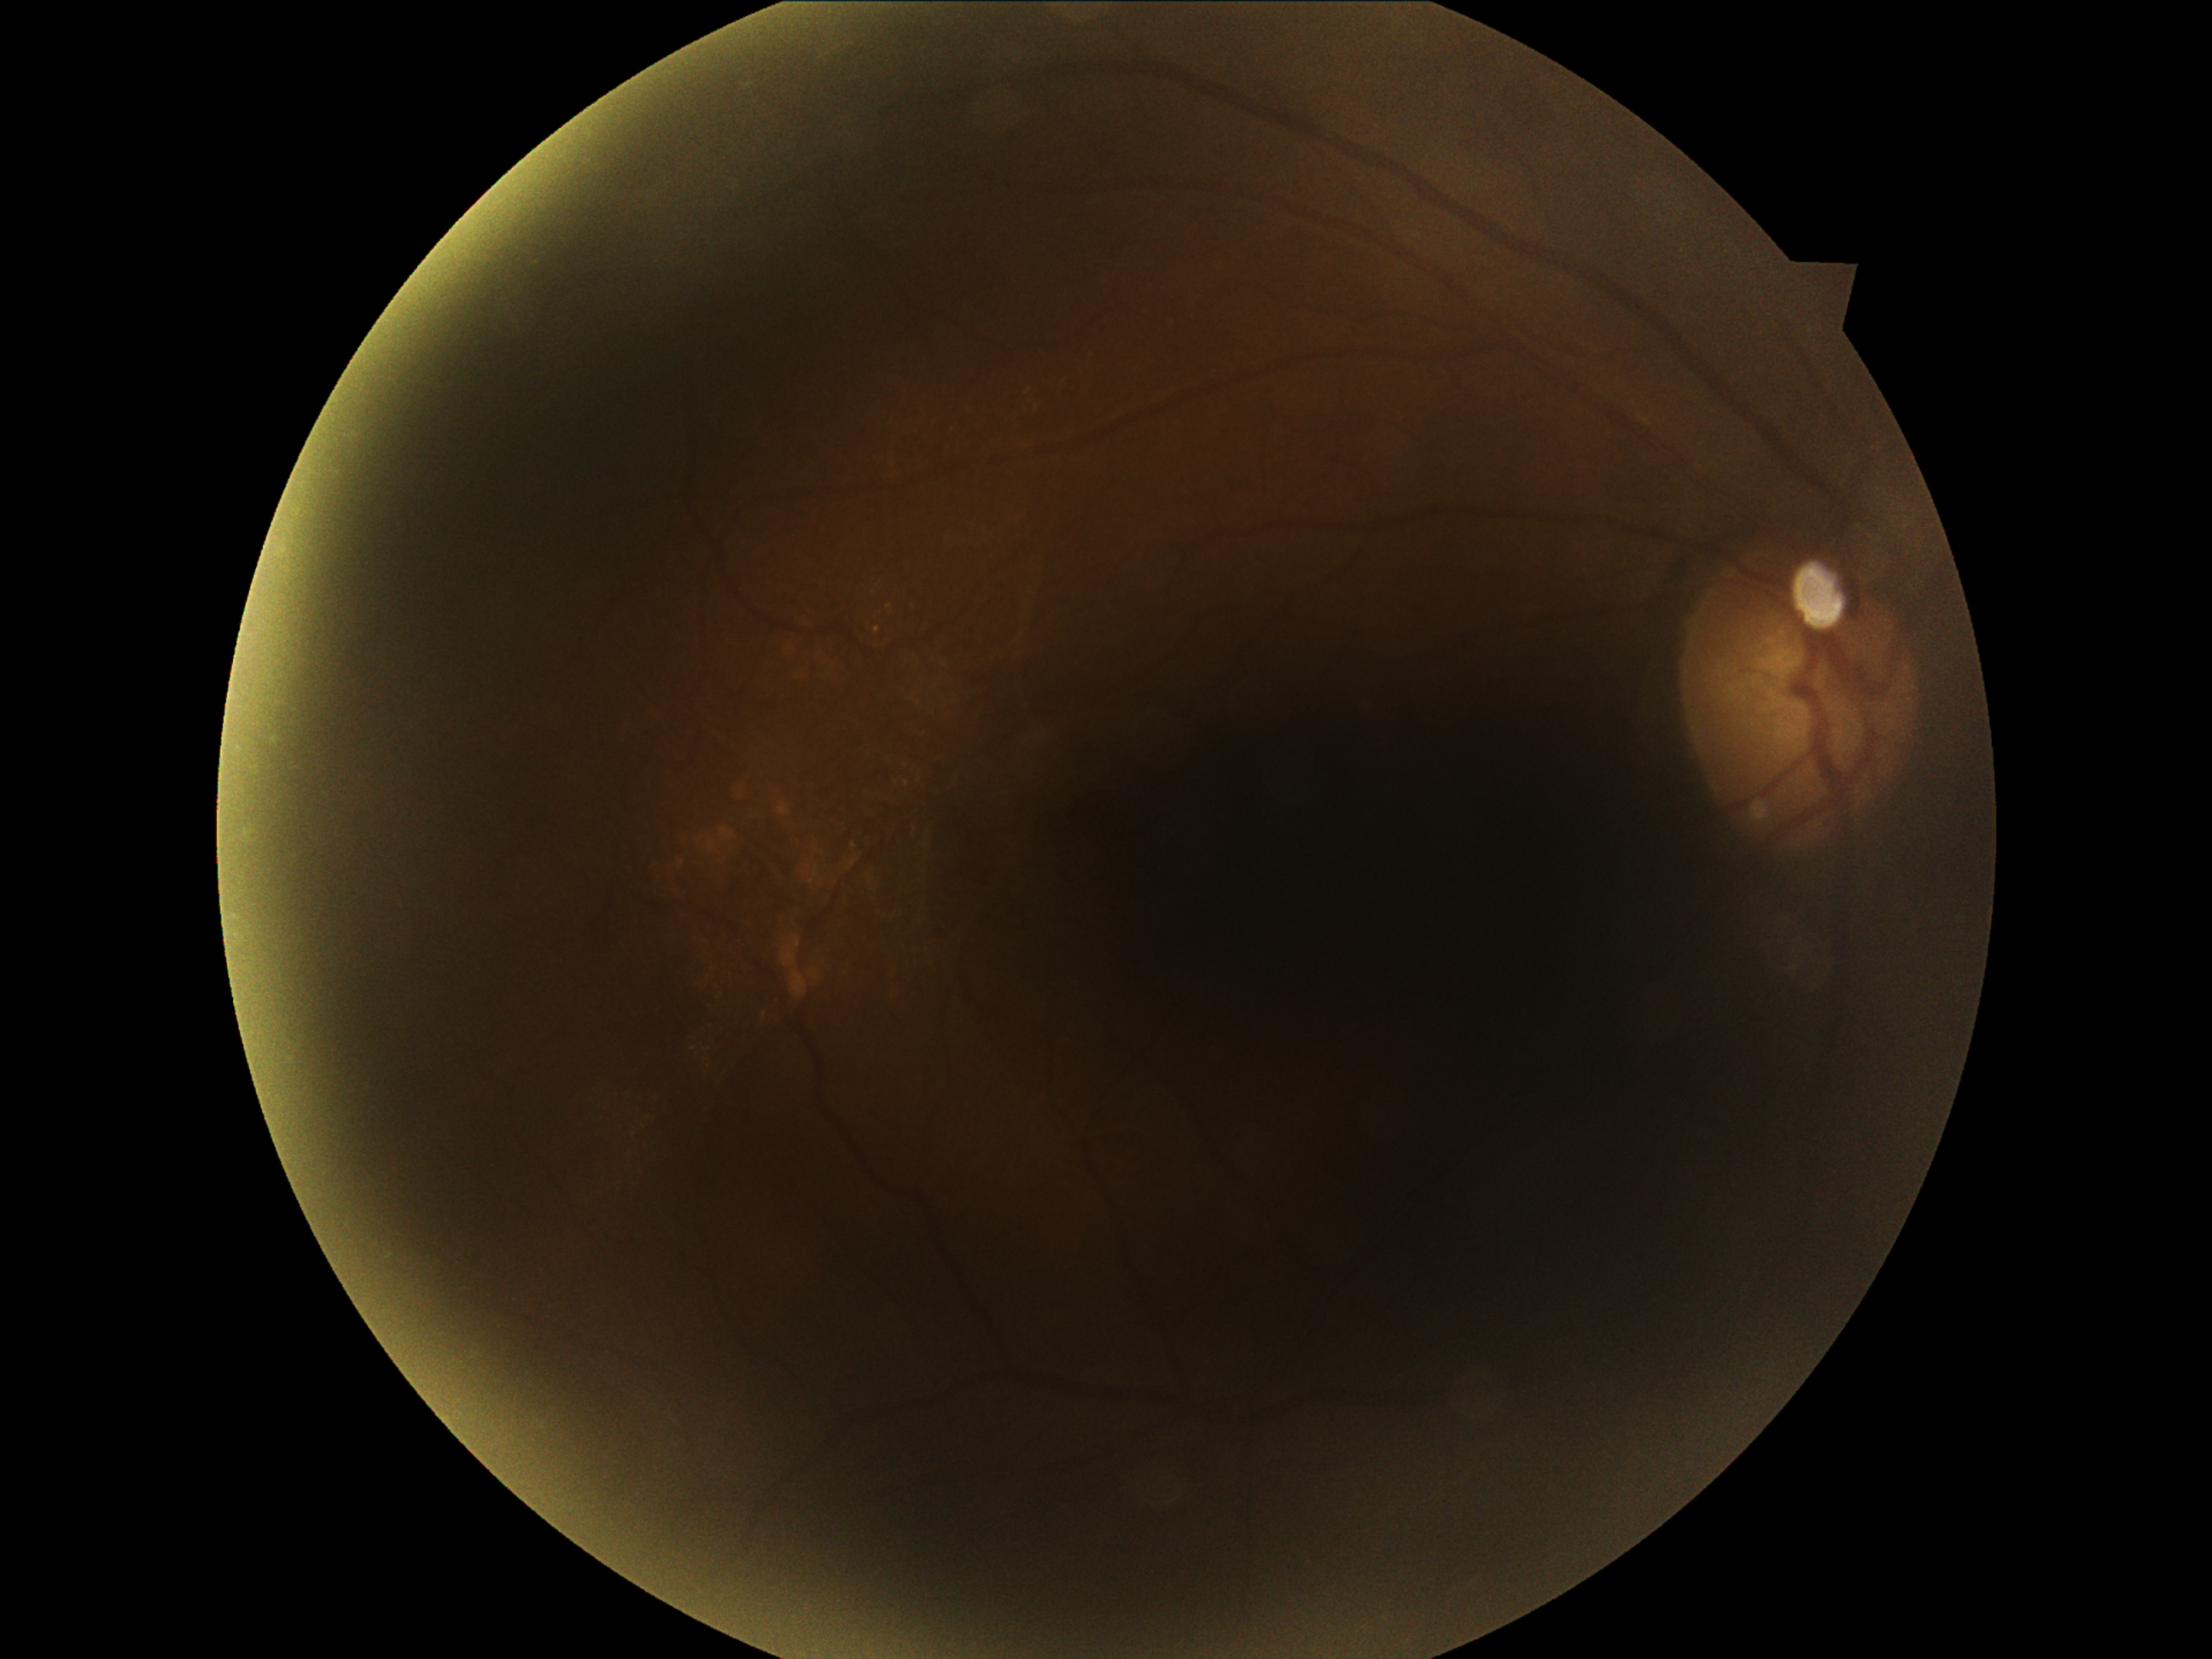
diabetic retinopathy=moderate non-proliferative diabetic retinopathy (grade 2).